Wide-field fundus photograph from neonatal ROP screening; 130° field of view (Natus RetCam Envision); 1440x1080px: 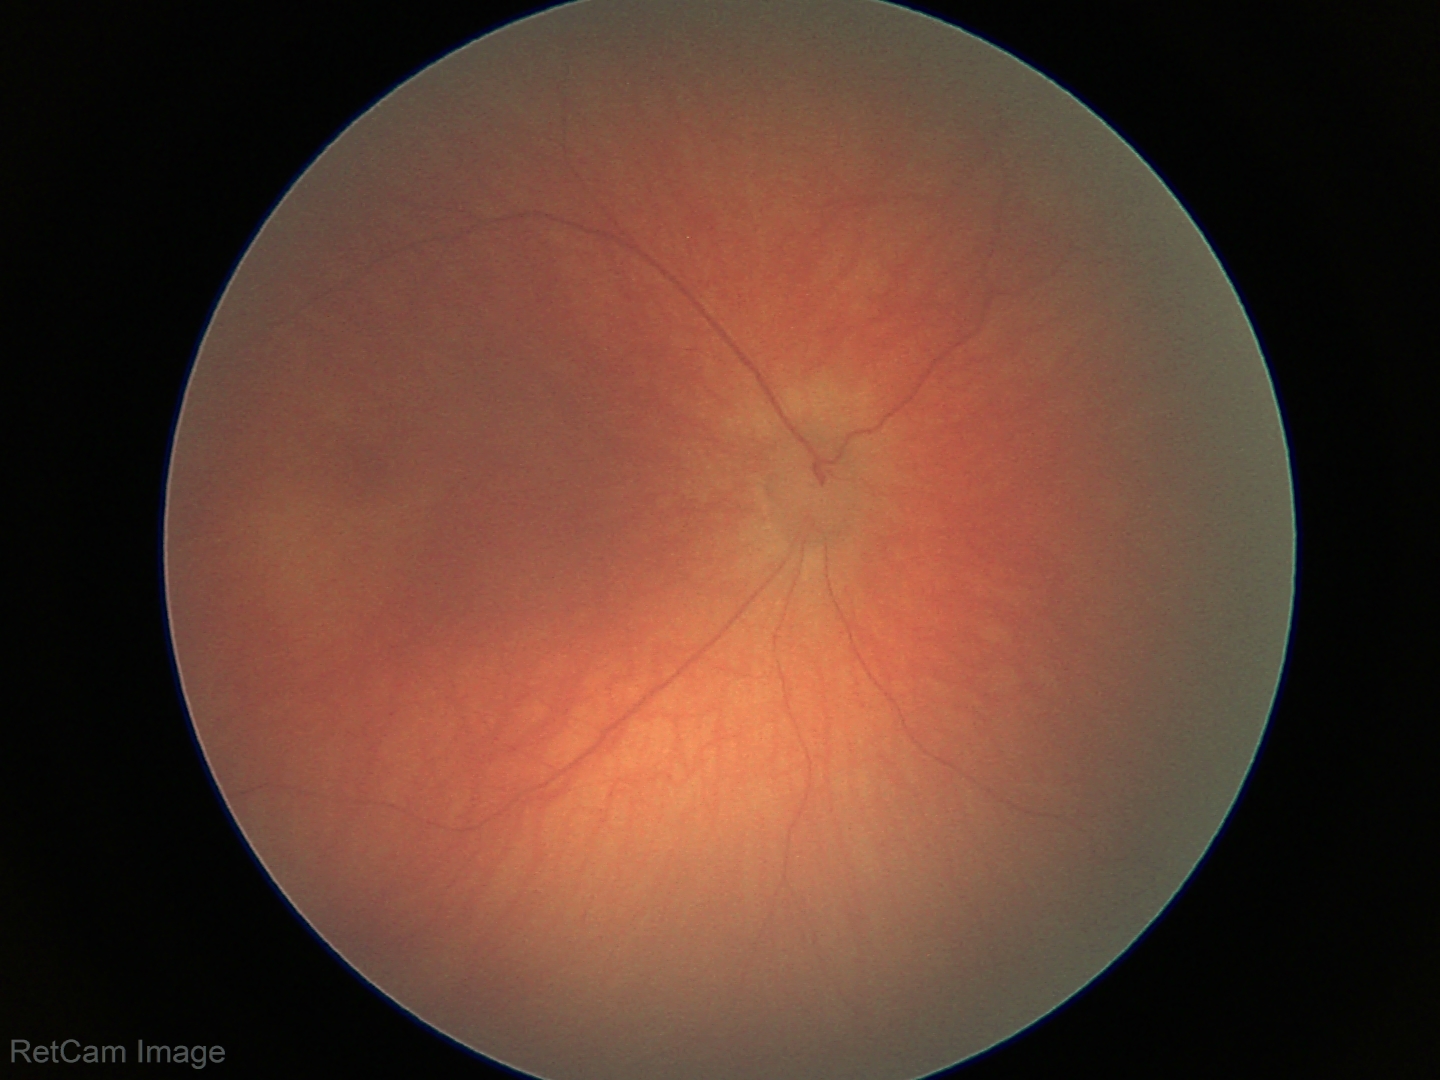
No retinal pathology identified on screening.